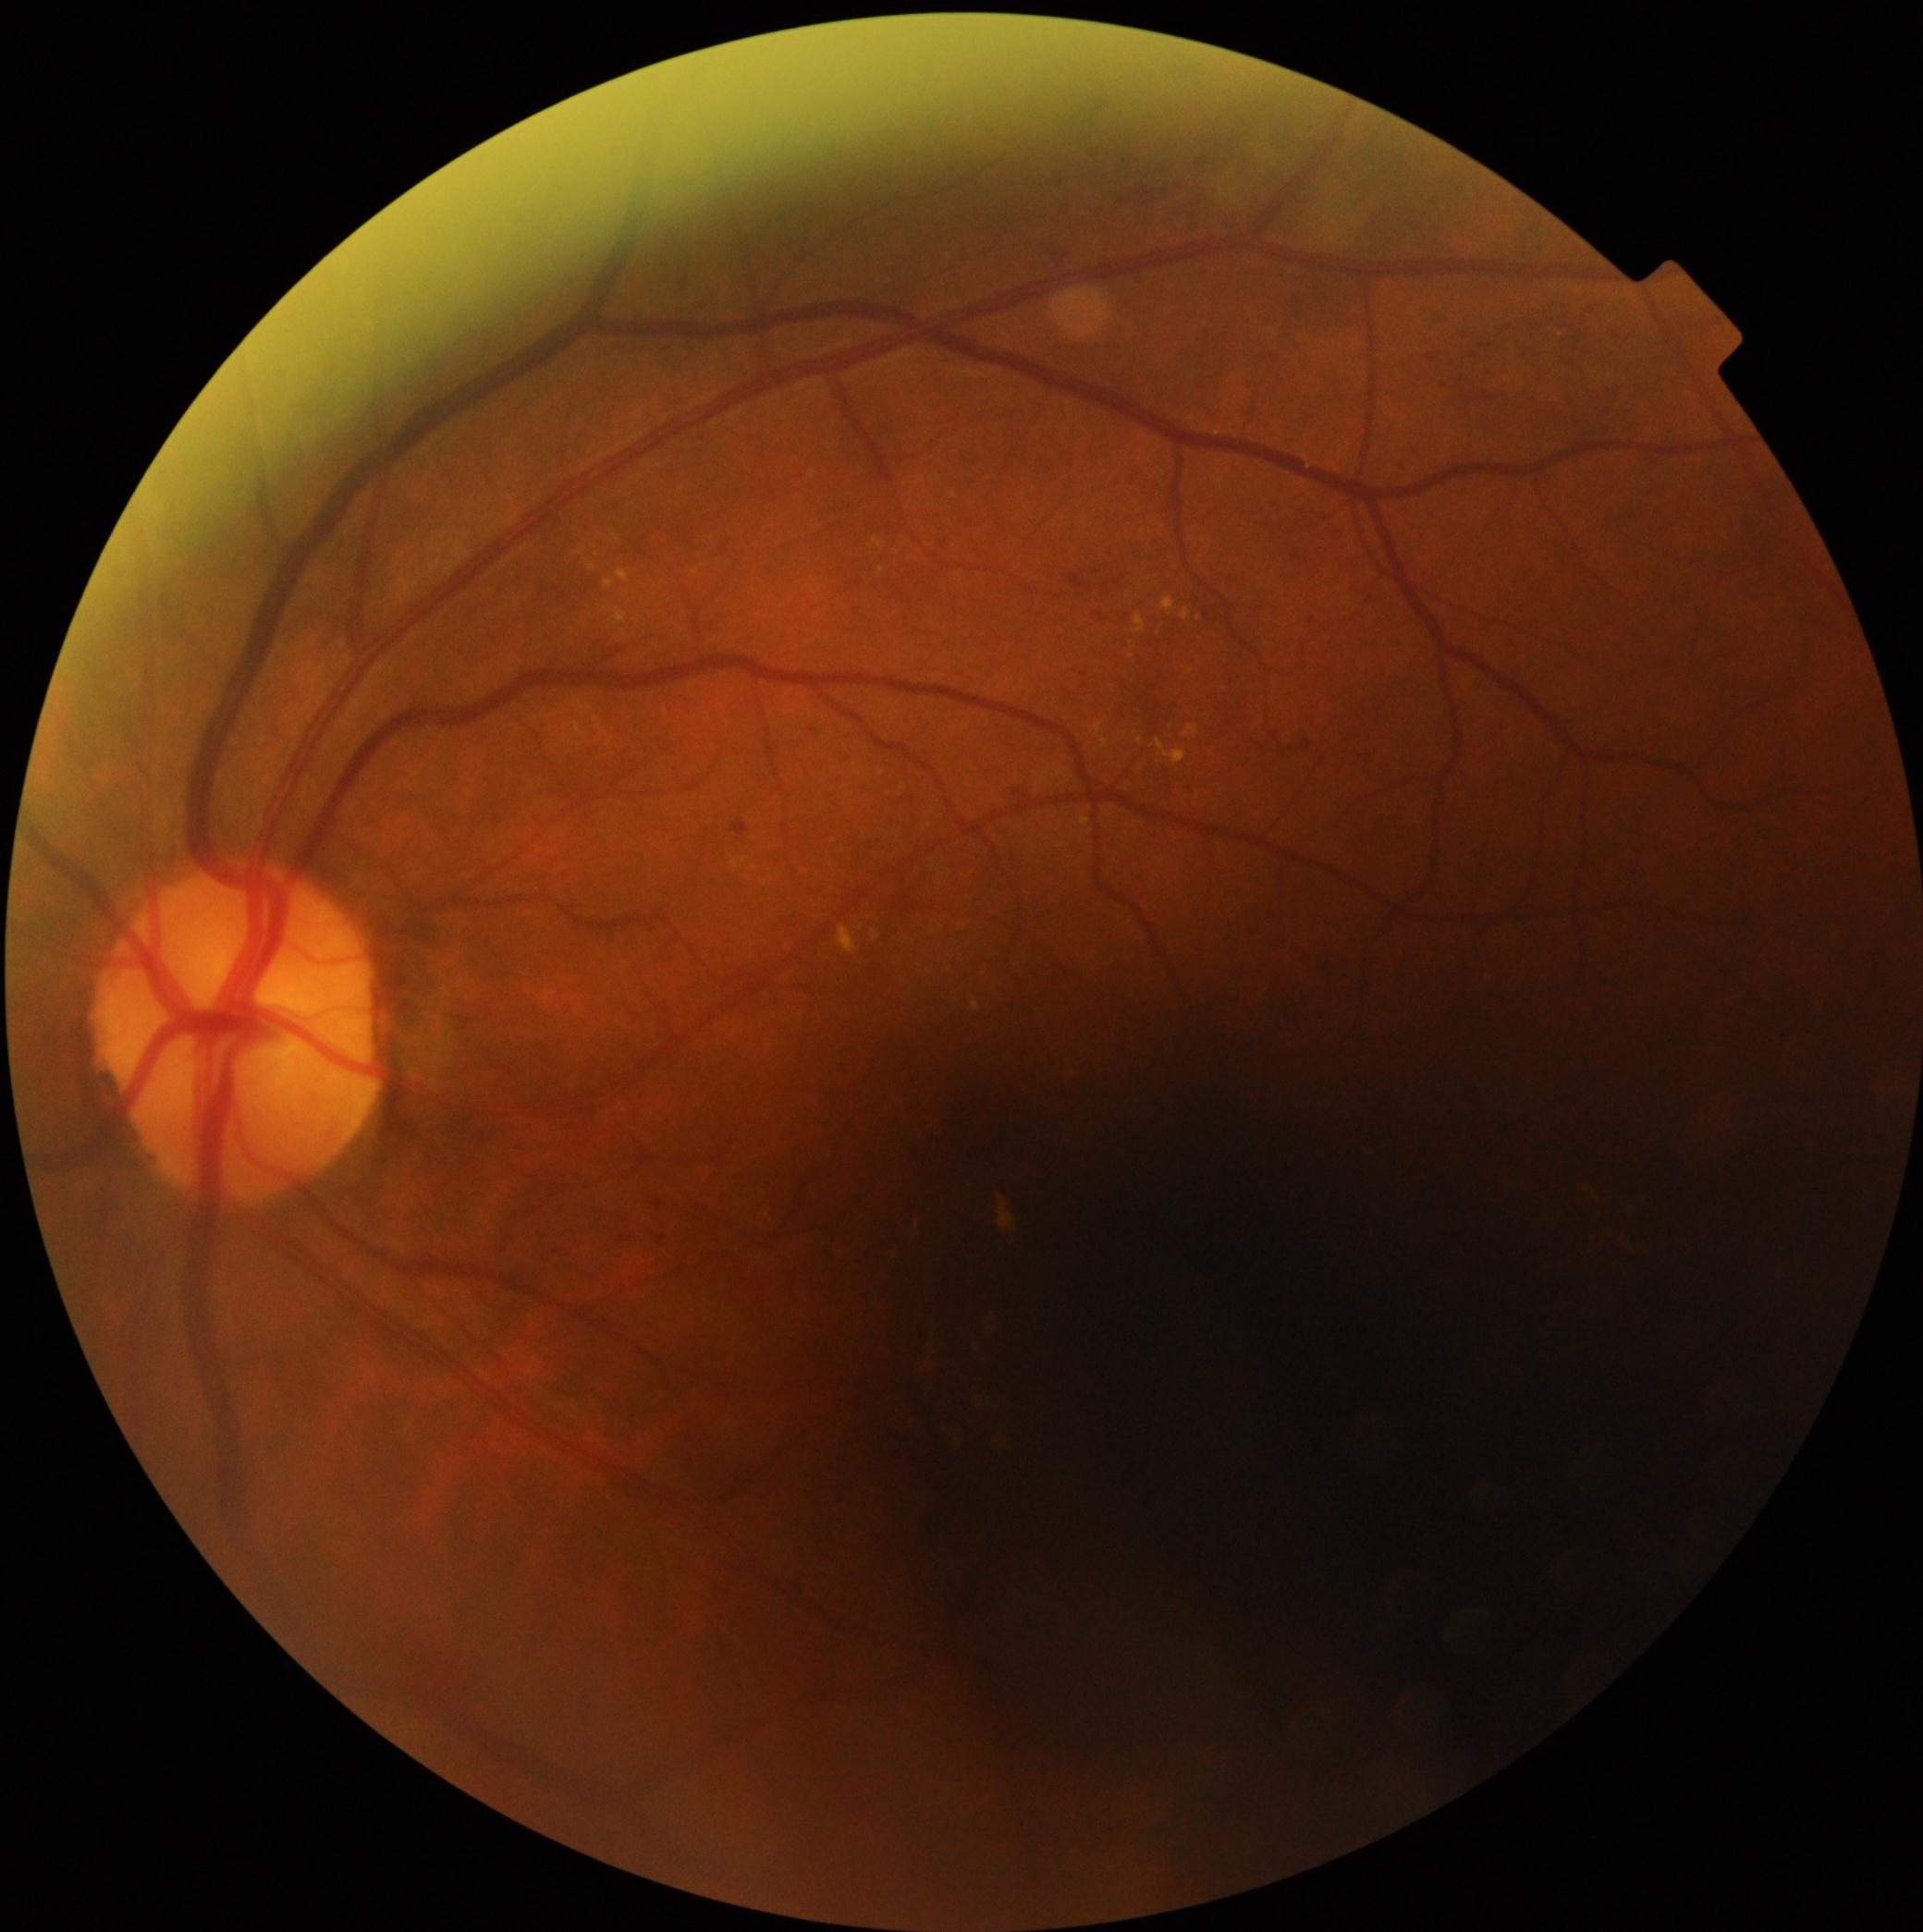

DR stage is grade 2 (moderate NPDR) — more than just microaneurysms but less than severe NPDR.